Image size 2352x1568, 45-degree field of view
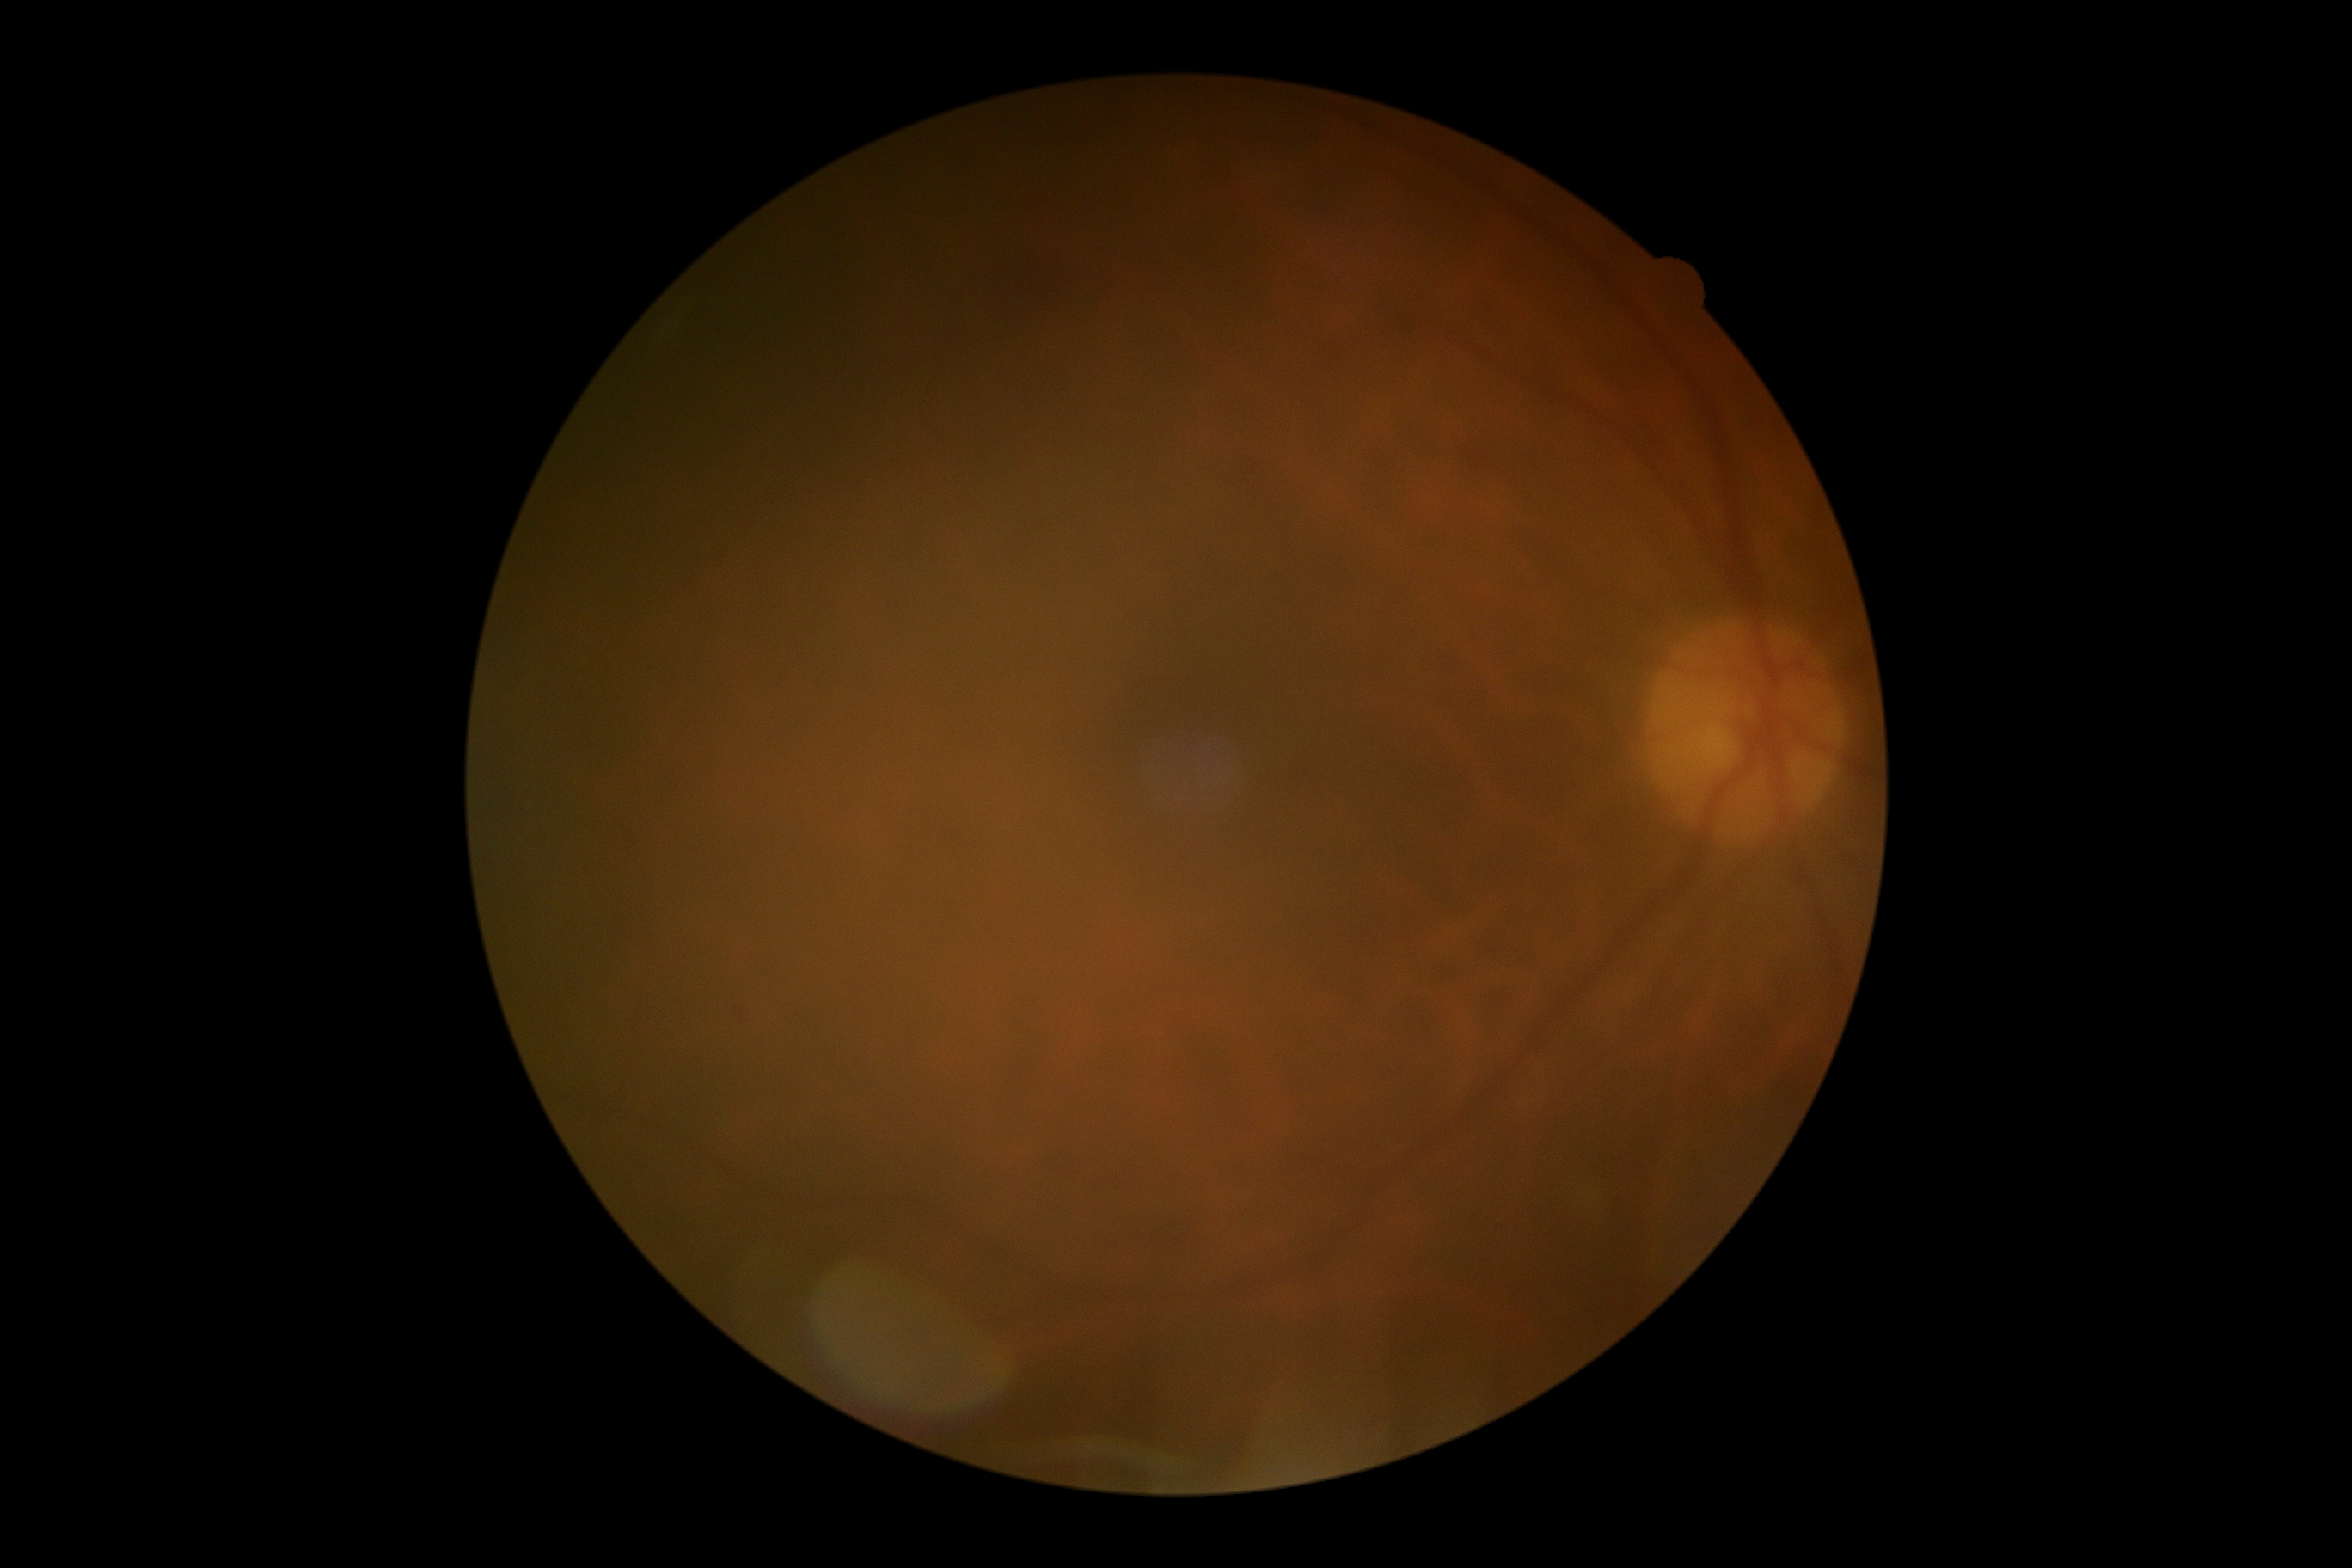

No DR findings. Diabetic retinopathy severity: grade 0.